1659 x 2212 pixels; captured on a Remidio Fundus on Phone (FOP) camera:
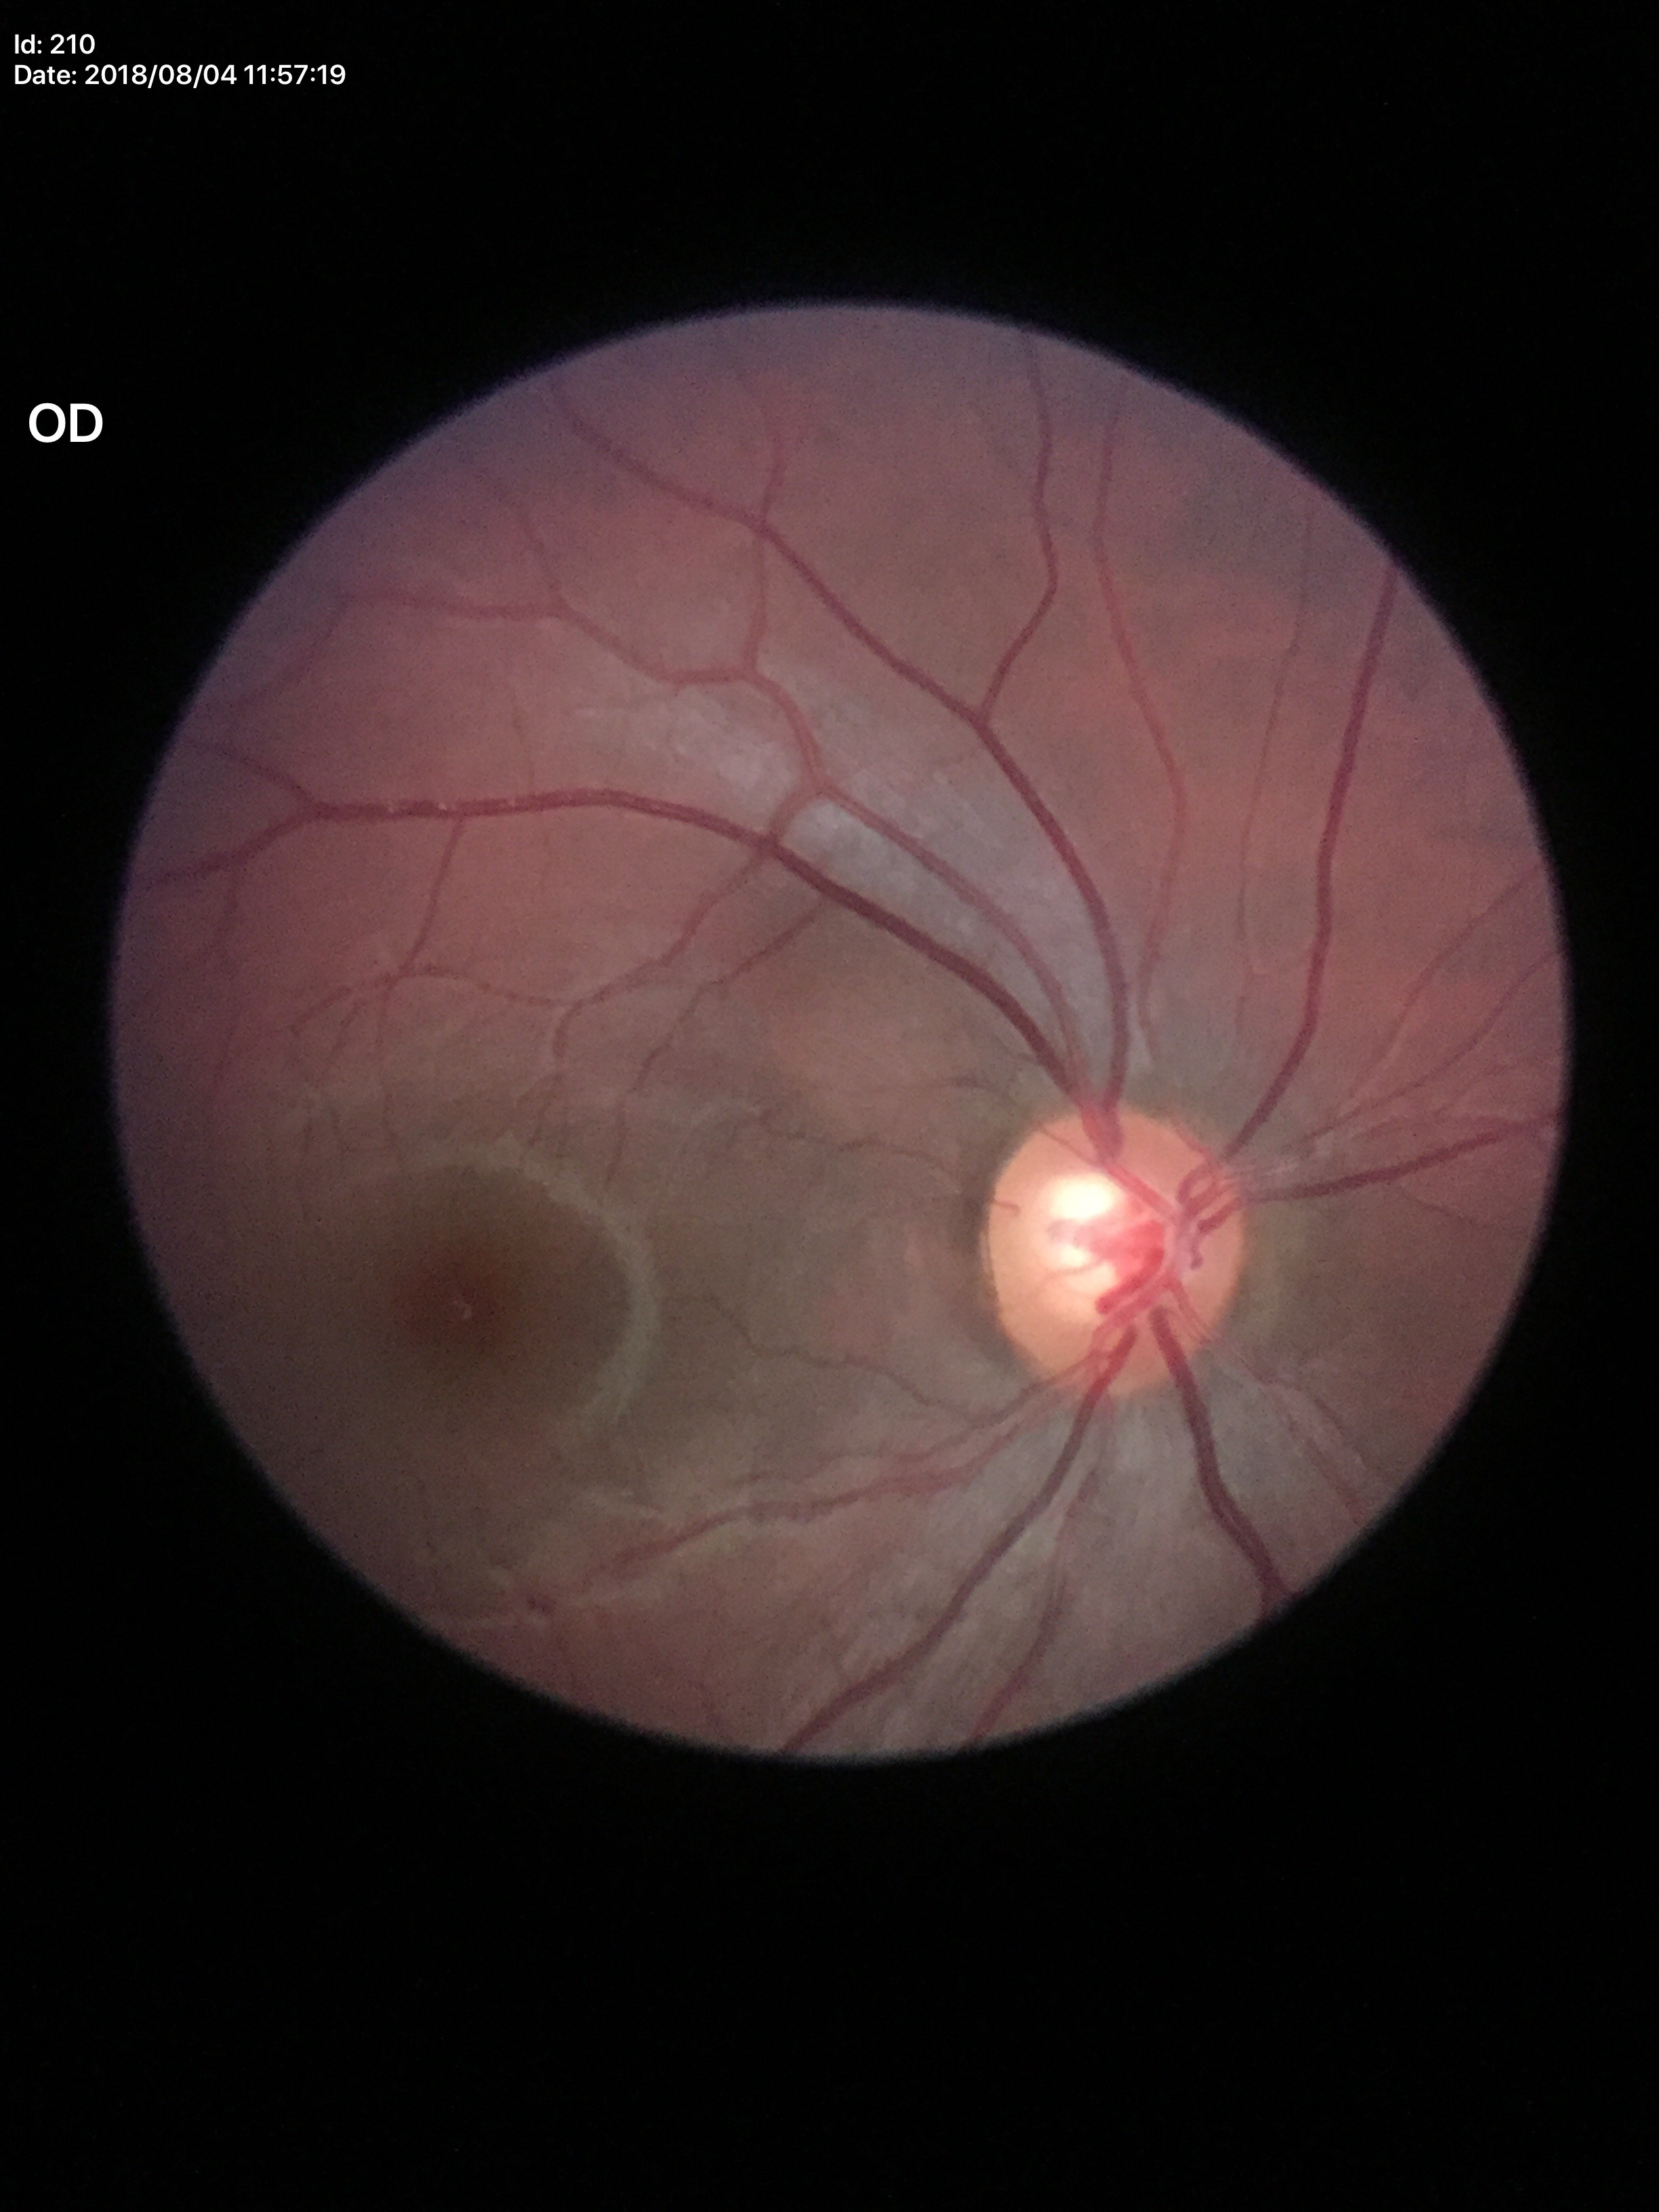
Glaucoma assessment: not suspect.
VCDR: 0.58.
HCDR is 0.66.
ACDR is 0.38.